Topcon TRC-50DX, image size 2228x1652:
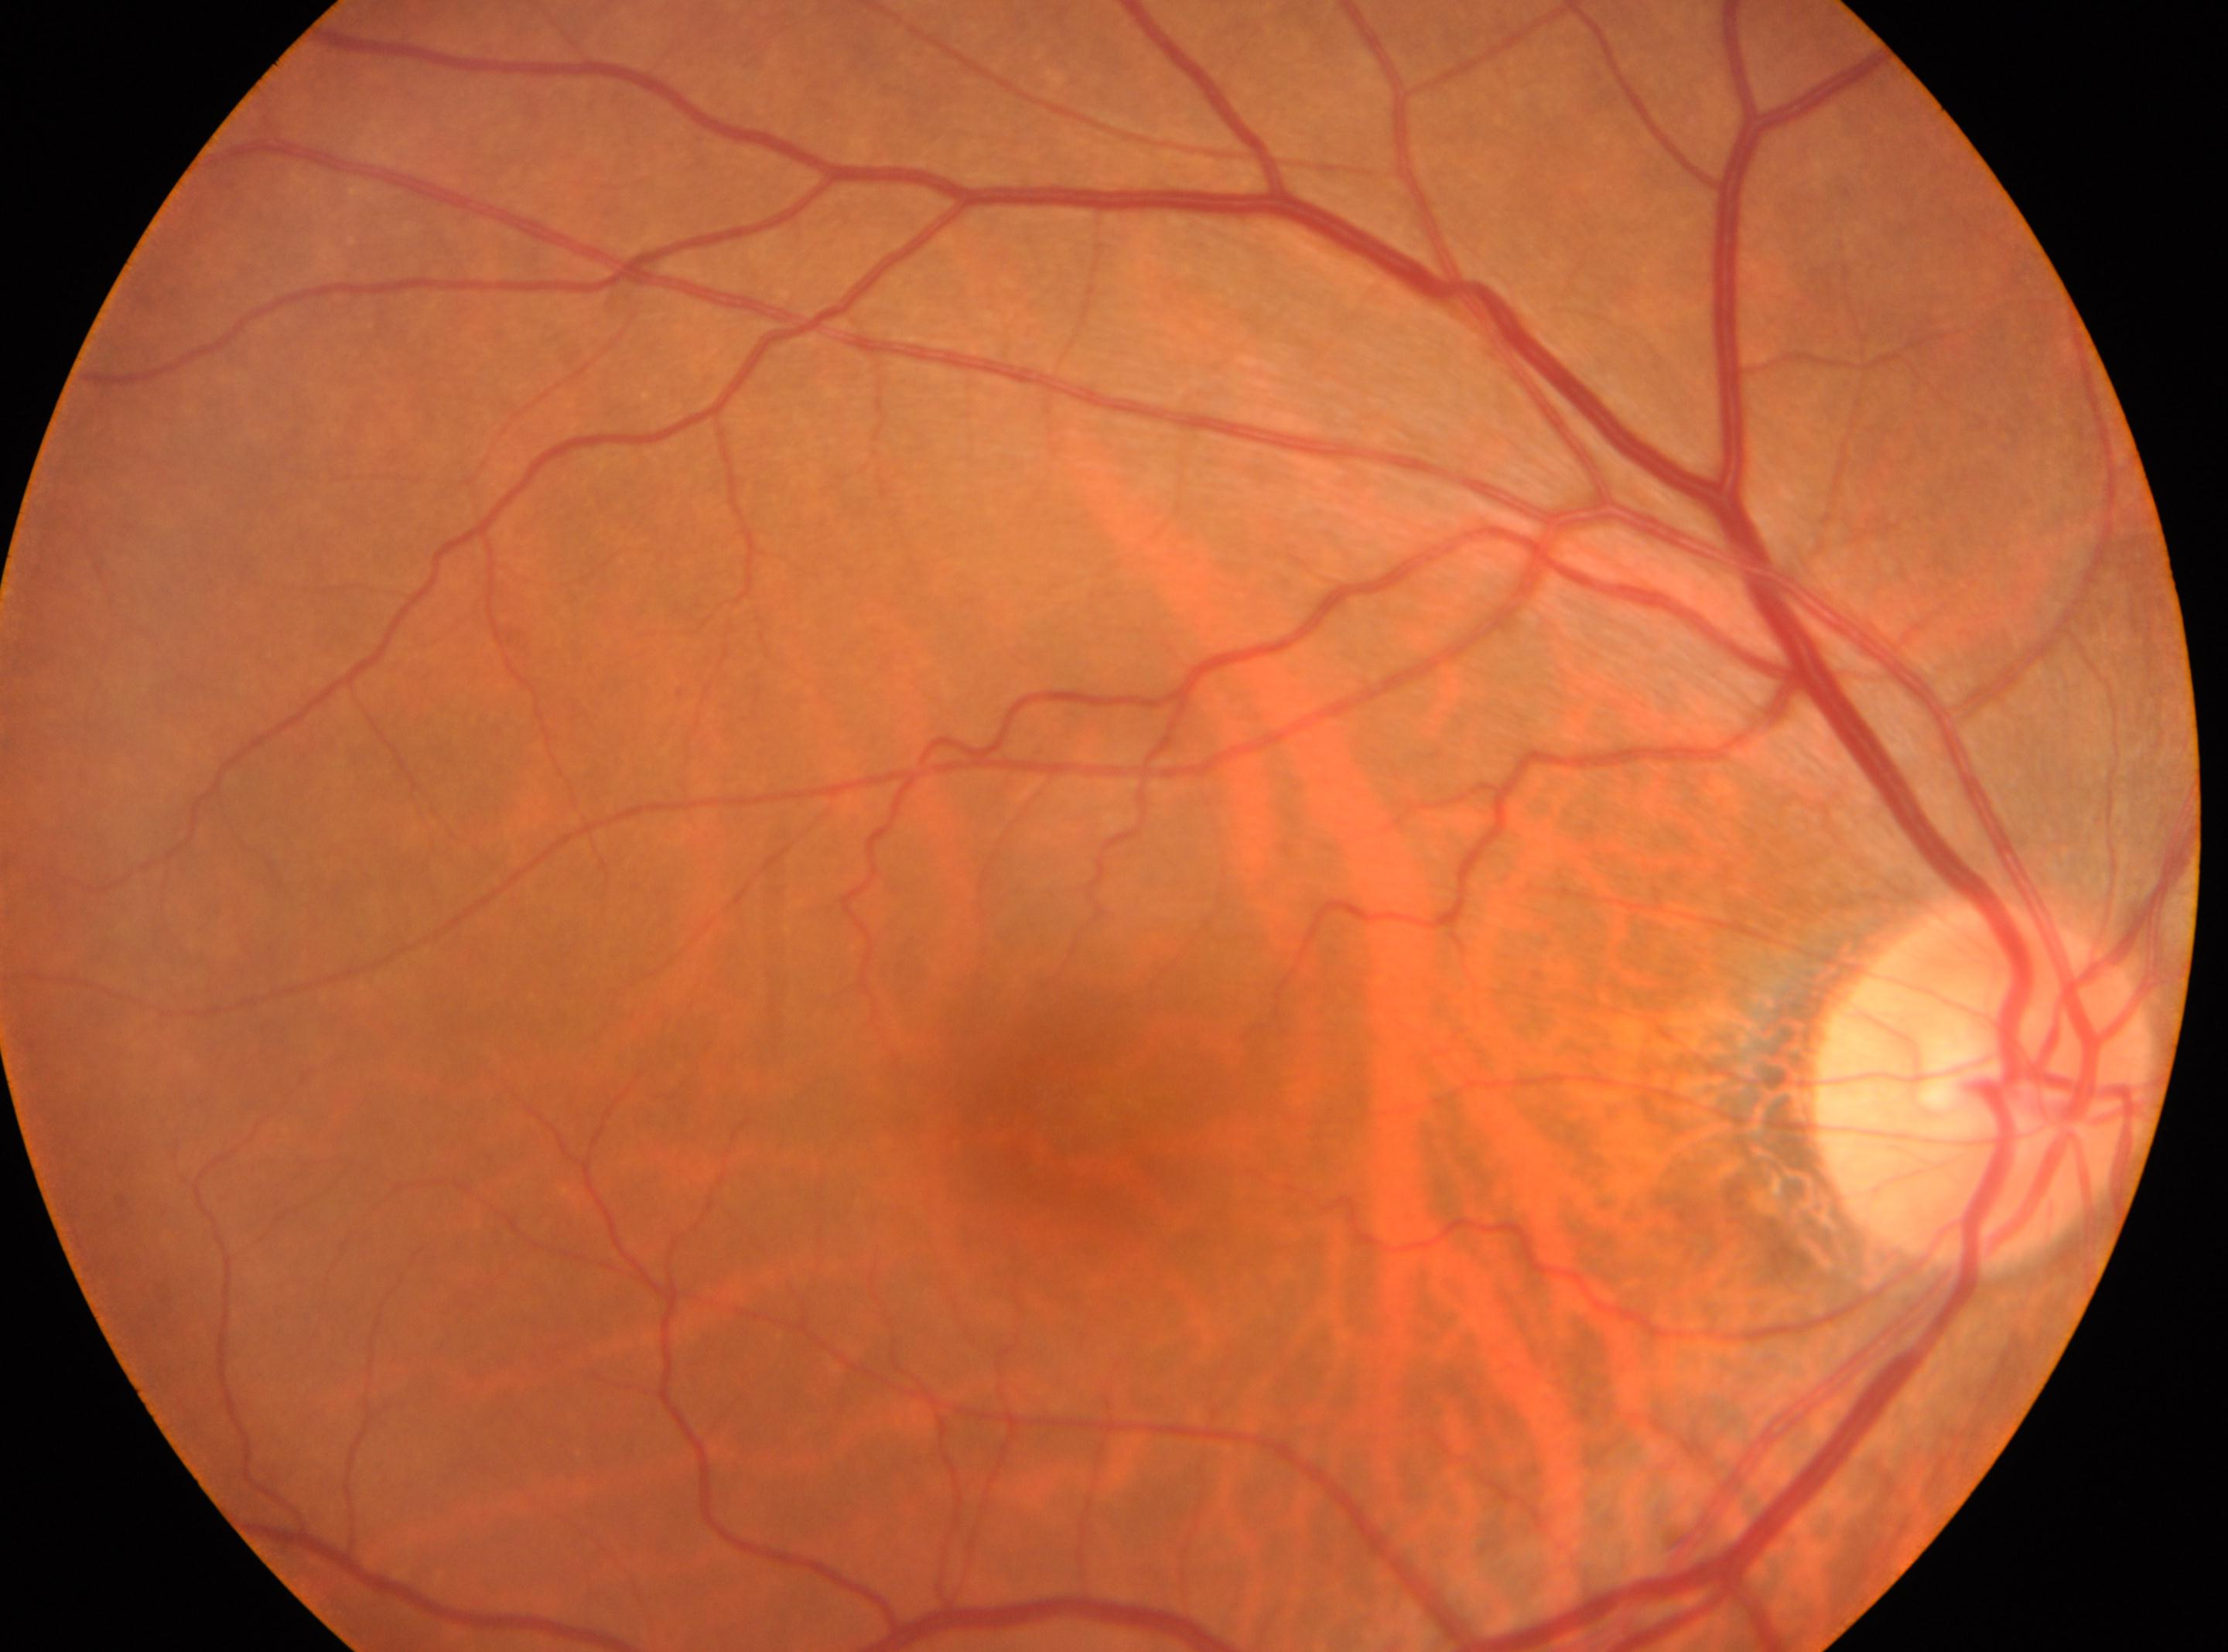

macula center: x=1038, y=1109; DR grade: no apparent retinopathy (0); laterality: right eye; optic nerve head: x=1985, y=1083.